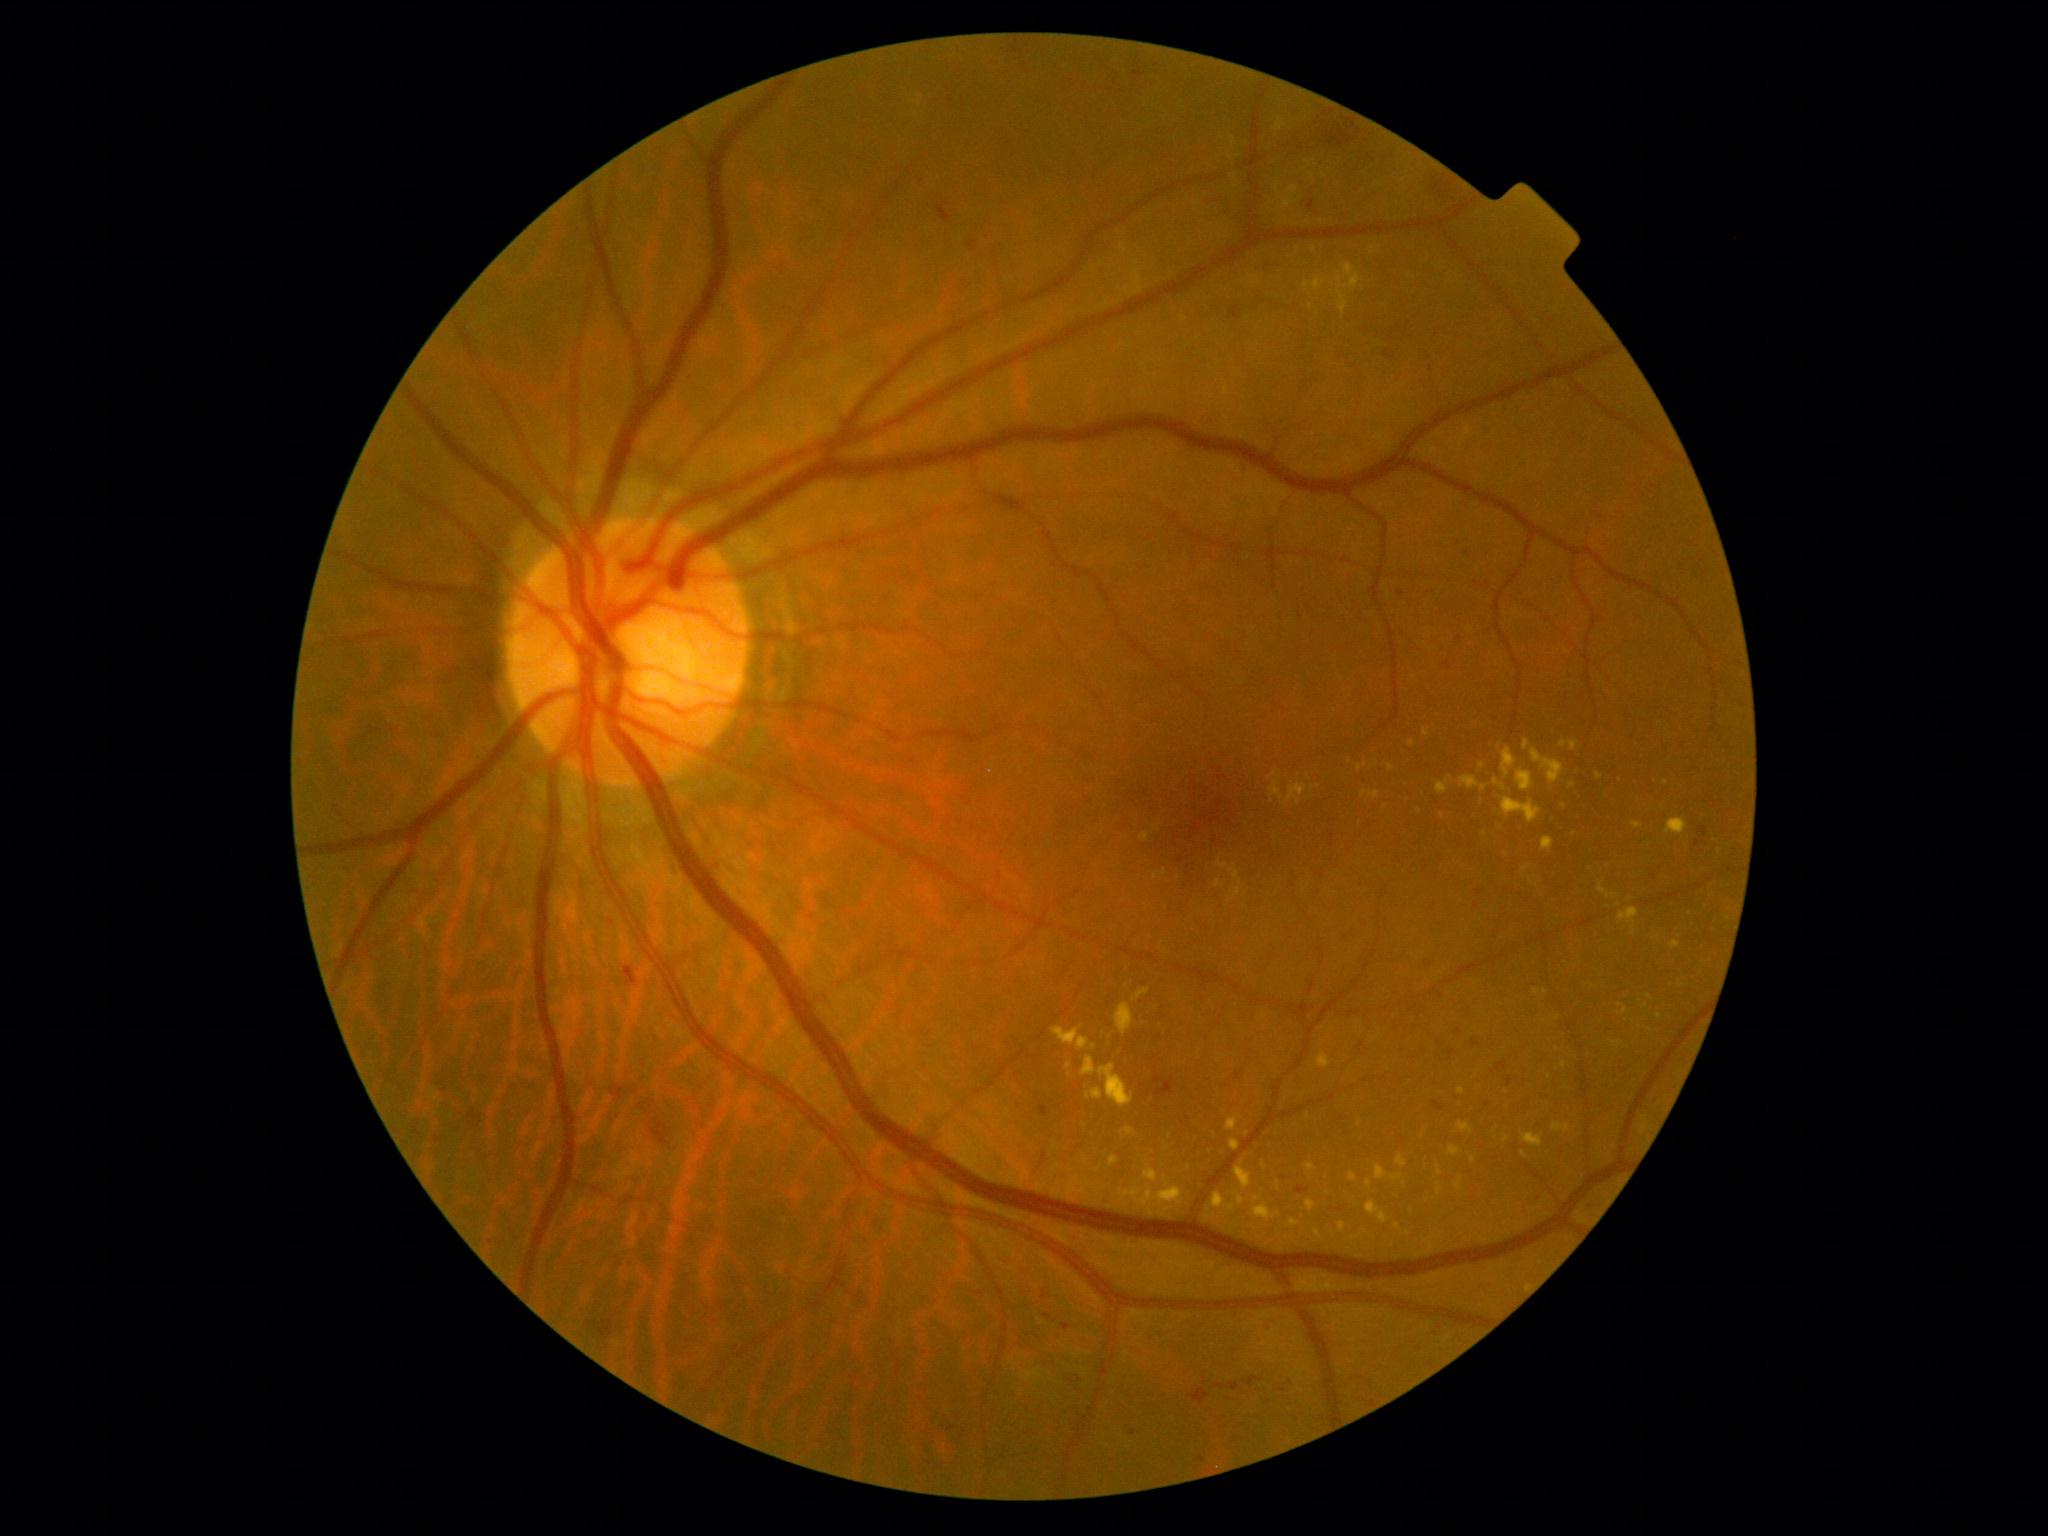

{"partial": true, "dr_grade": 2, "lesions": {"ex": [[1667, 819, 1688, 836], [1116, 1004, 1133, 1037], [1226, 1117, 1239, 1132], [1305, 1163, 1317, 1172], [1140, 833, 1150, 842], [1215, 881, 1225, 888], [1523, 1133, 1543, 1148], [1149, 1191, 1180, 1198], [1367, 1179, 1373, 1189], [1153, 871, 1168, 881], [1277, 1182, 1281, 1192], [1502, 798, 1542, 823], [1449, 1146, 1460, 1158]], "ex_small": [[1507, 1092], [1650, 998], [1564, 1066], [1659, 1017], [1620, 780], [1412, 743]]}}